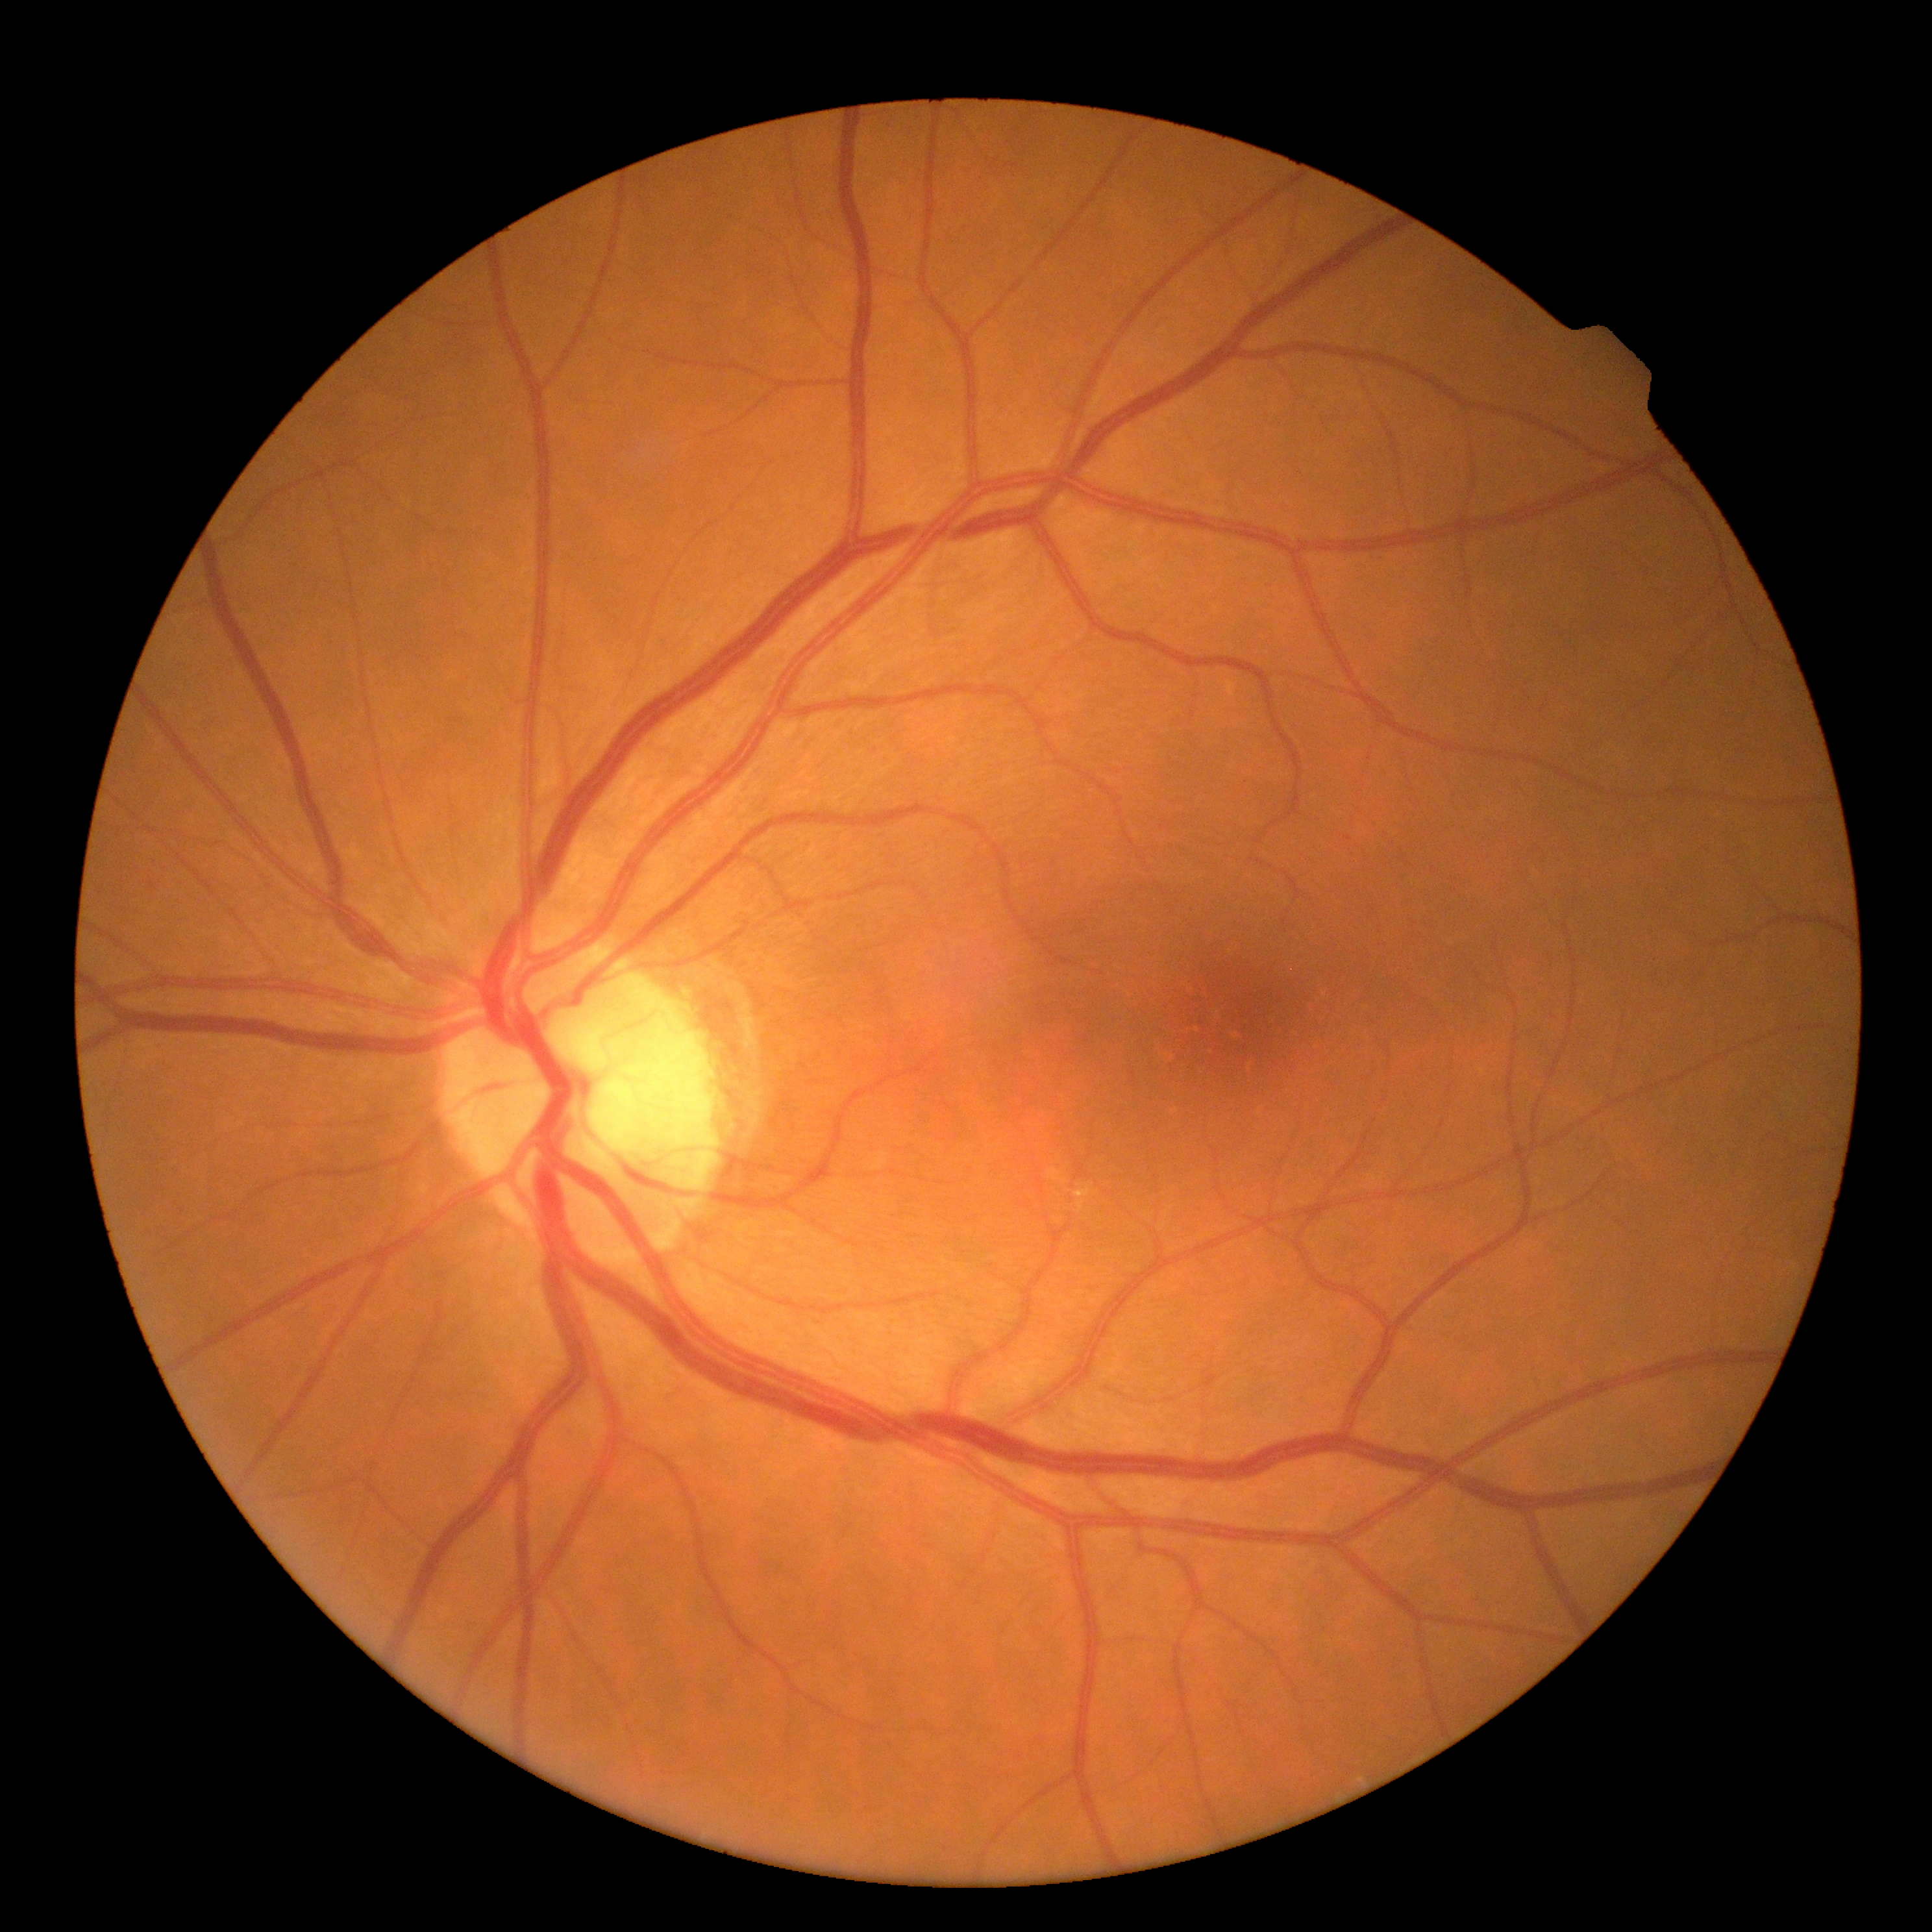

diabetic retinopathy (DR): no apparent retinopathy (grade 0).